Acquired with a NIDEK AFC-230 · diabetic retinopathy graded by the modified Davis classification · posterior pole color fundus photograph: 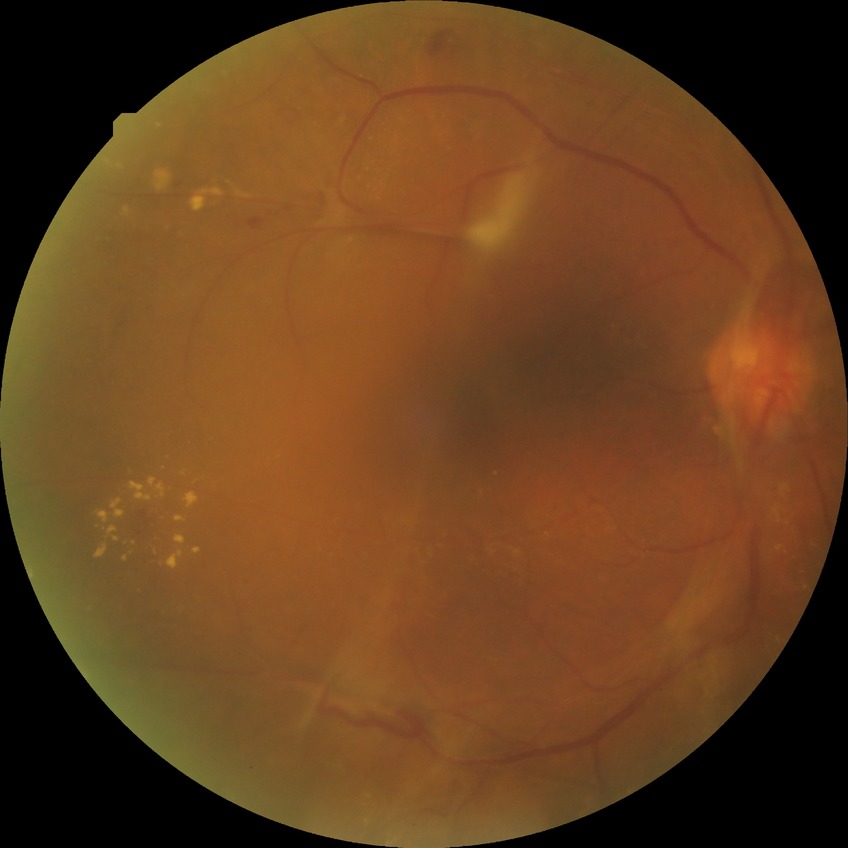

  davis_grade: PDR (proliferative diabetic retinopathy)